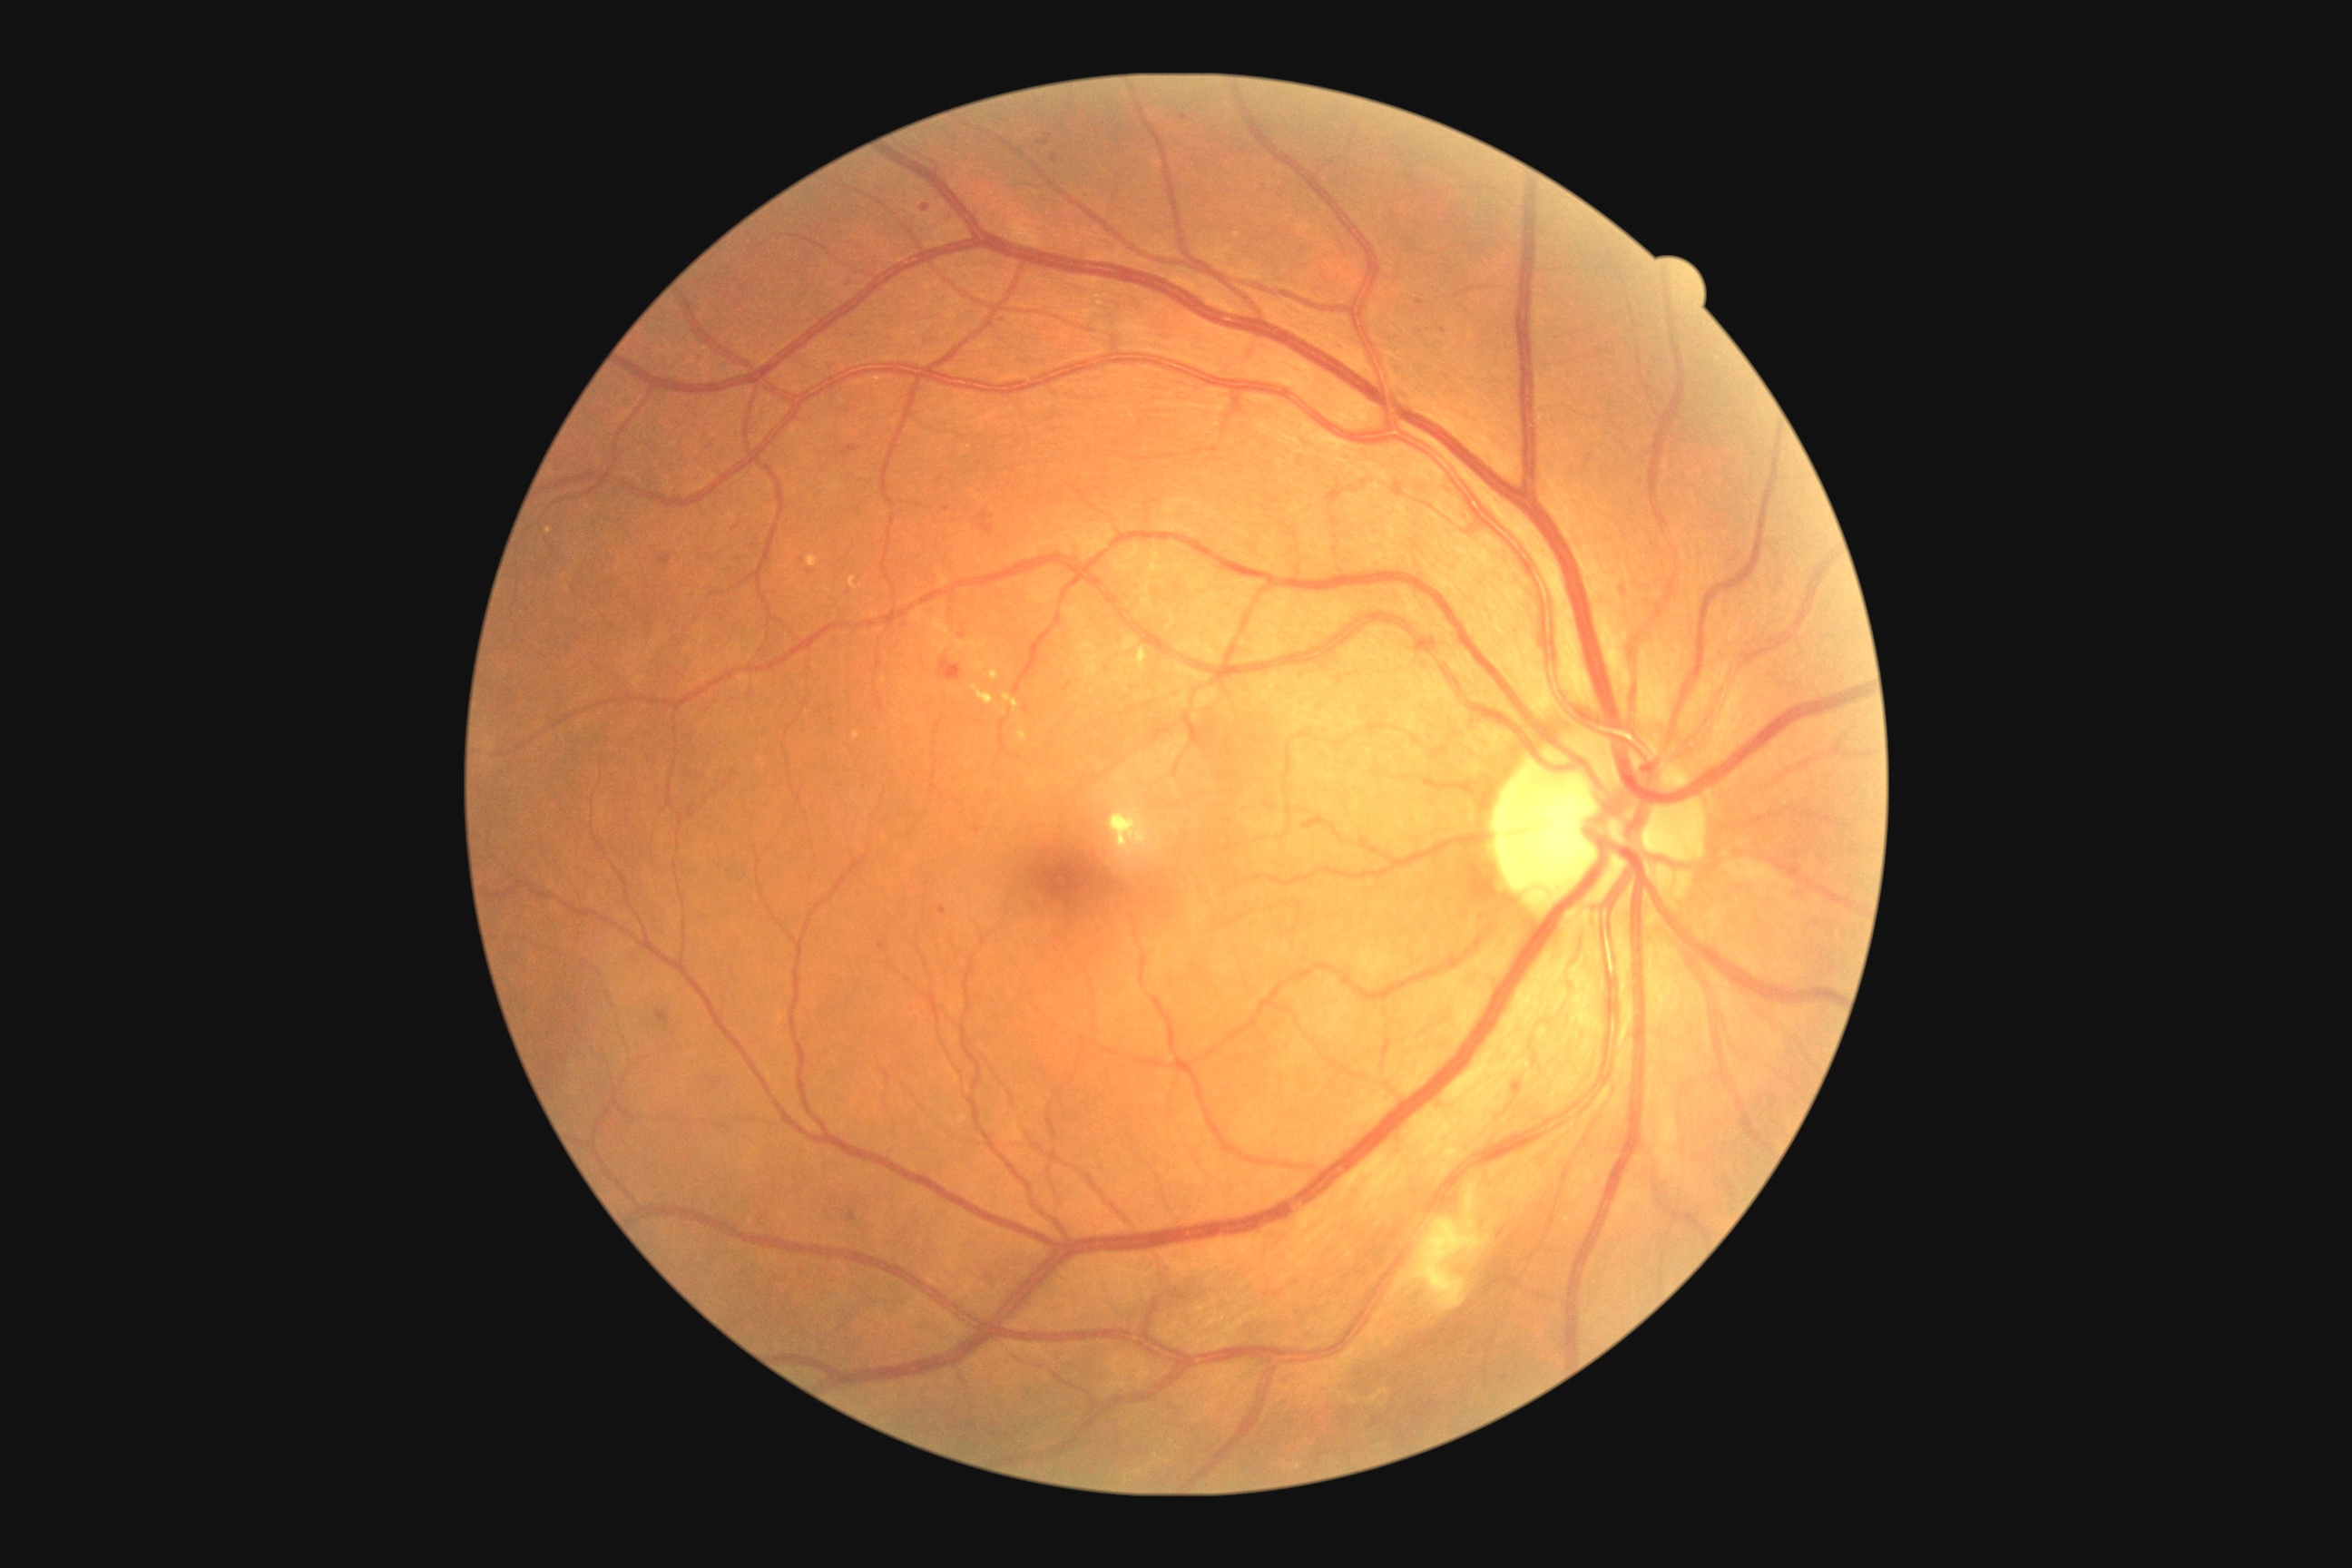
Diabetic retinopathy (DR): grade 2 — more than just microaneurysms but less than severe NPDR
Representative lesions:
hemorrhages (HEs) = rect(979, 513, 994, 534); rect(939, 658, 961, 681)
hard exudates (EXs) (subset) = rect(1122, 647, 1148, 671); rect(1108, 803, 1162, 861); rect(1003, 692, 1019, 714); rect(1017, 730, 1028, 743); rect(972, 685, 995, 705); rect(852, 732, 859, 741); rect(990, 662, 1003, 681)
Smaller EXs around pt(1004, 714)
microaneurysms (MAs) (subset) = rect(923, 204, 930, 213); rect(1513, 1083, 1524, 1095); rect(1665, 578, 1676, 603); rect(808, 571, 816, 574); rect(959, 632, 966, 640); rect(843, 446, 861, 456); rect(939, 906, 948, 916)
Smaller MAs around pt(1624, 590); pt(829, 368); pt(1277, 502); pt(1054, 159); pt(1184, 119)
soft exudates (SEs) = rect(1386, 1181, 1491, 1315)